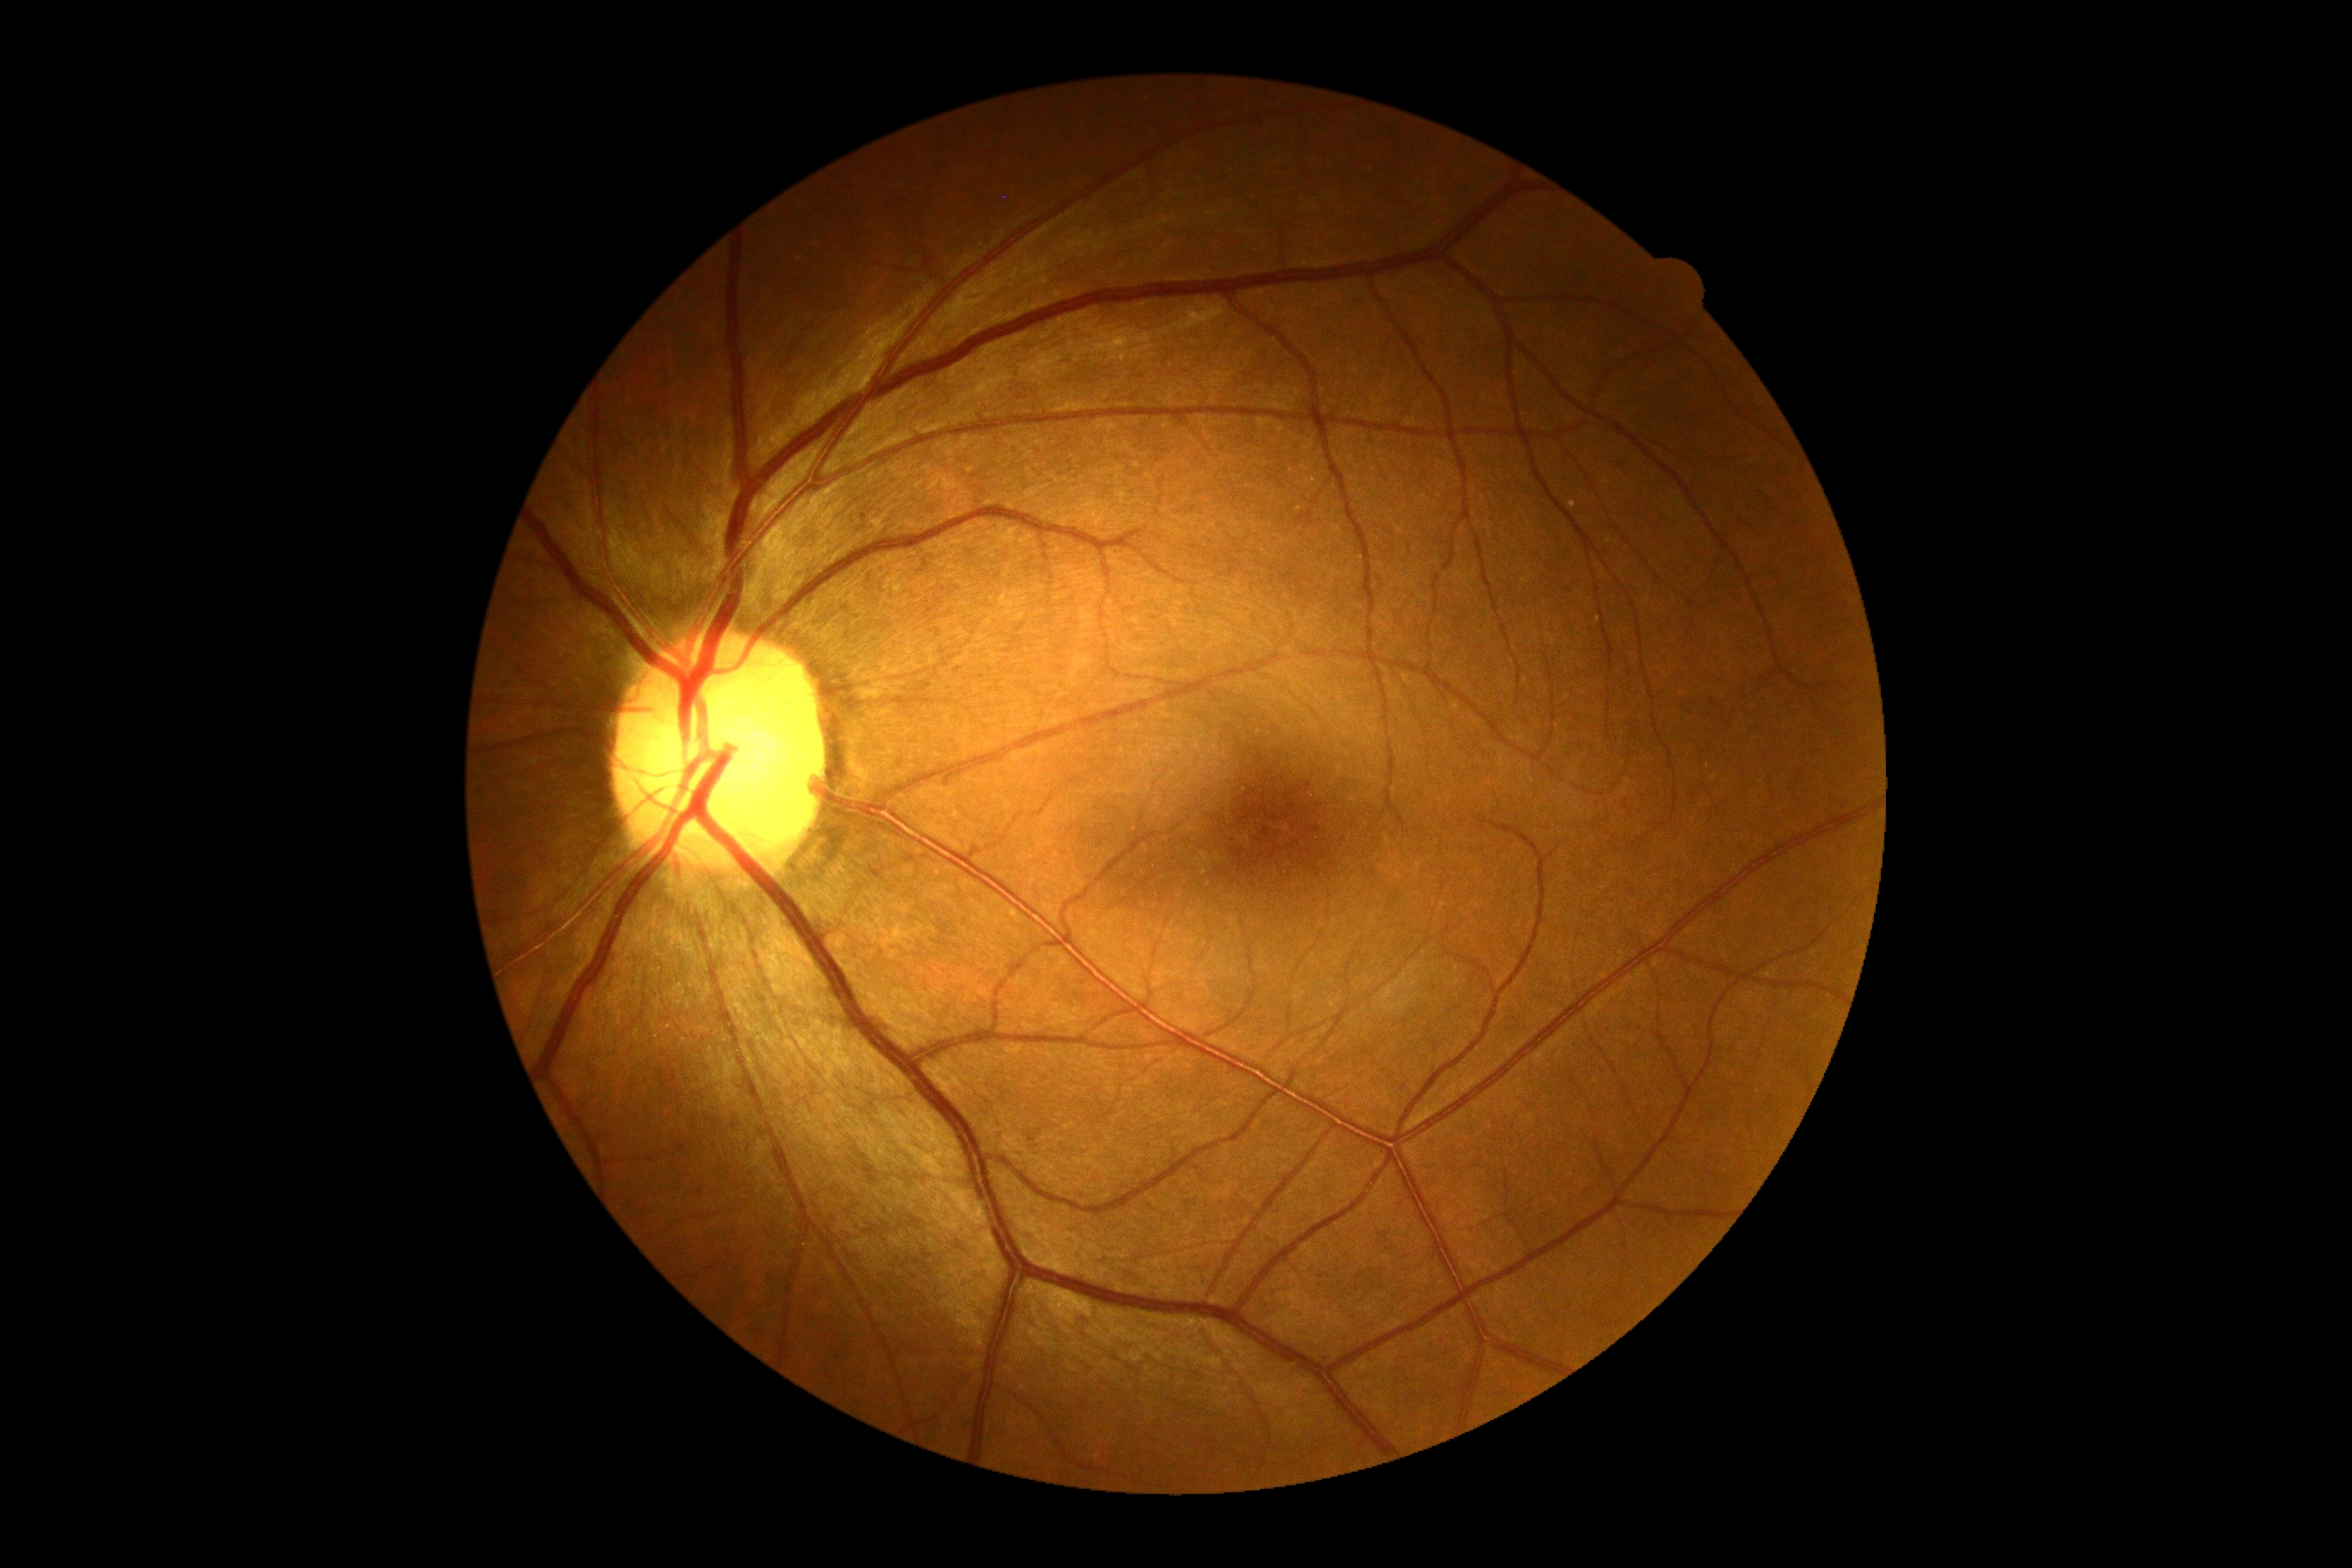

– DR impression — no apparent DR
– diabetic retinopathy severity — 0/4